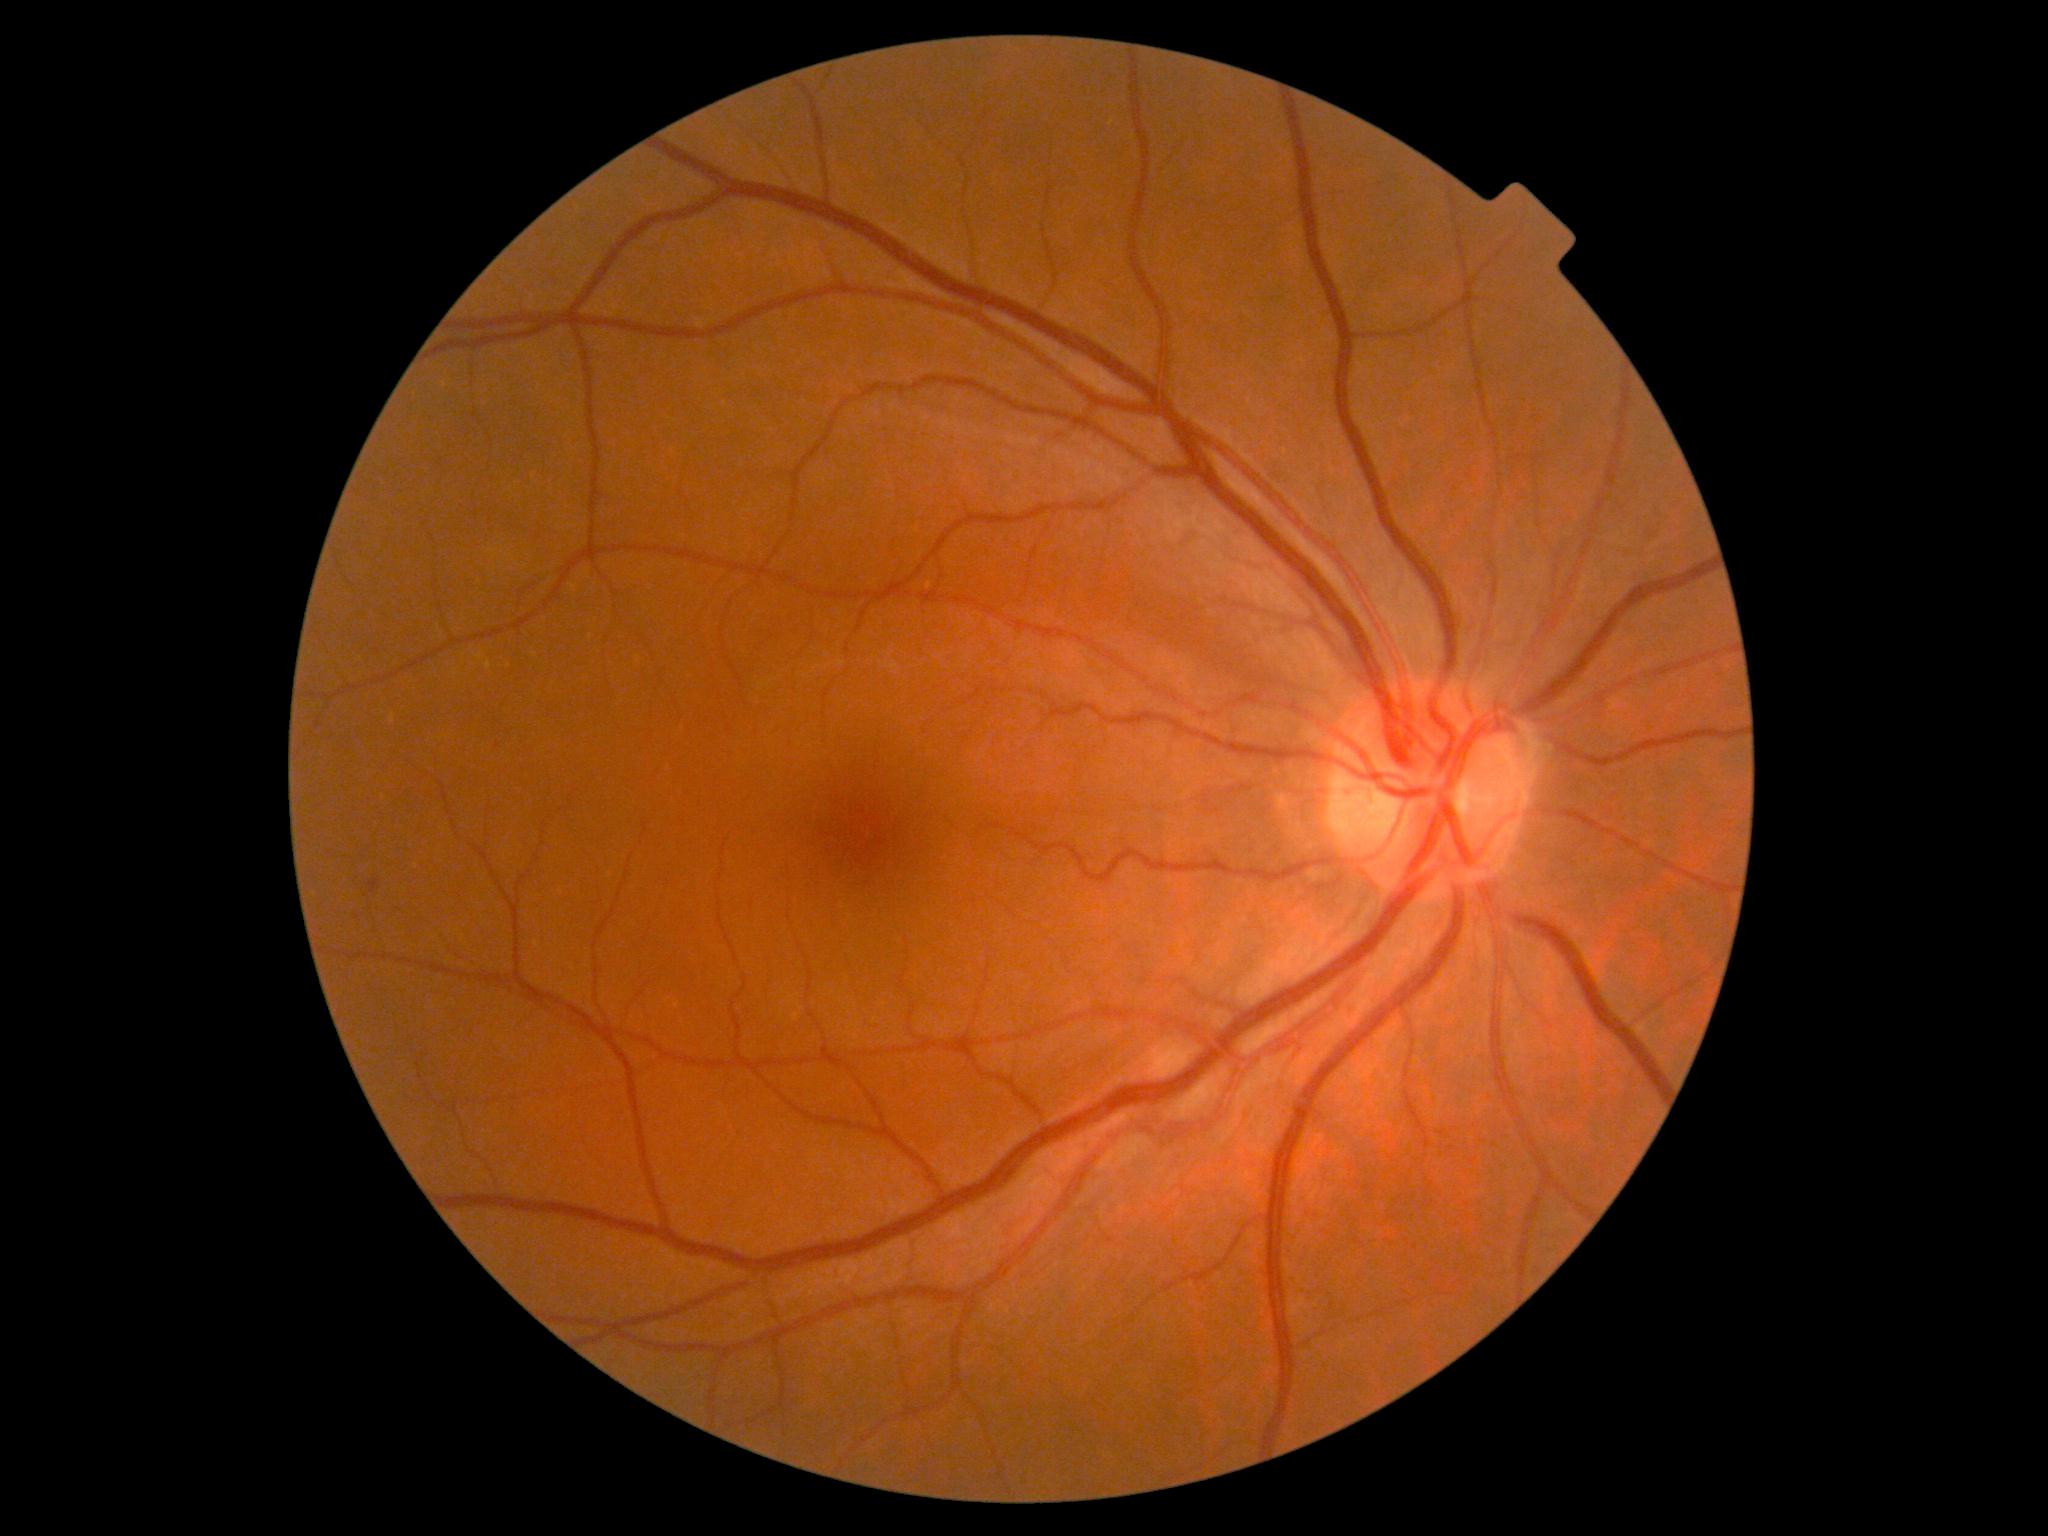 DR is grade 1 (mild NPDR).